848x848px.
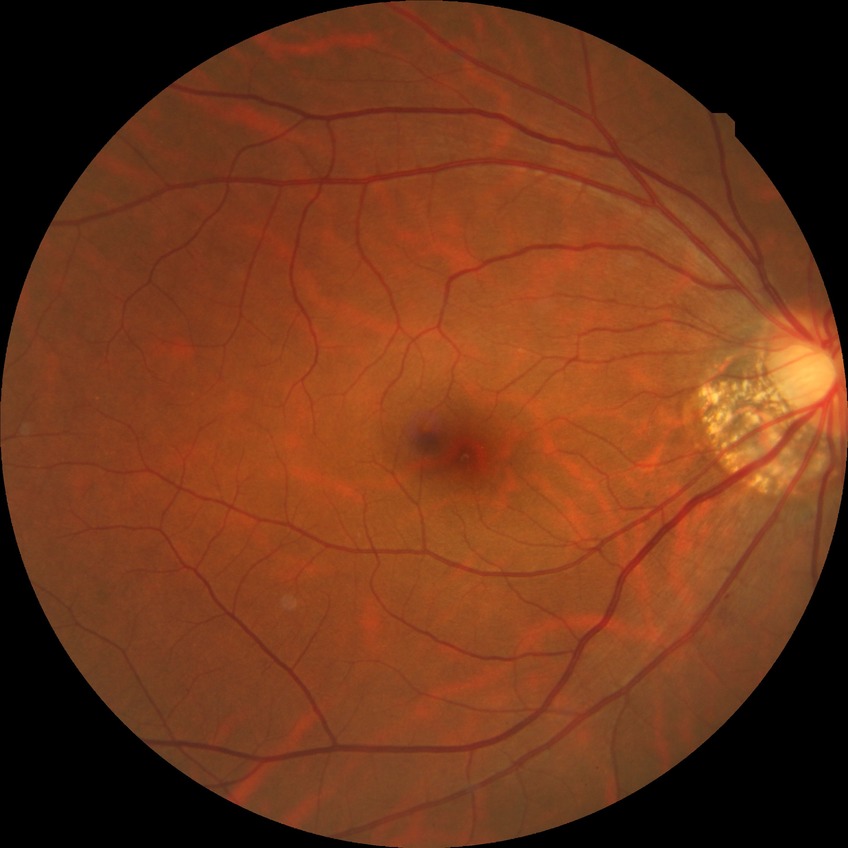 diabetic retinopathy (DR) = simple diabetic retinopathy (SDR).